Color fundus image, 1725x1721.
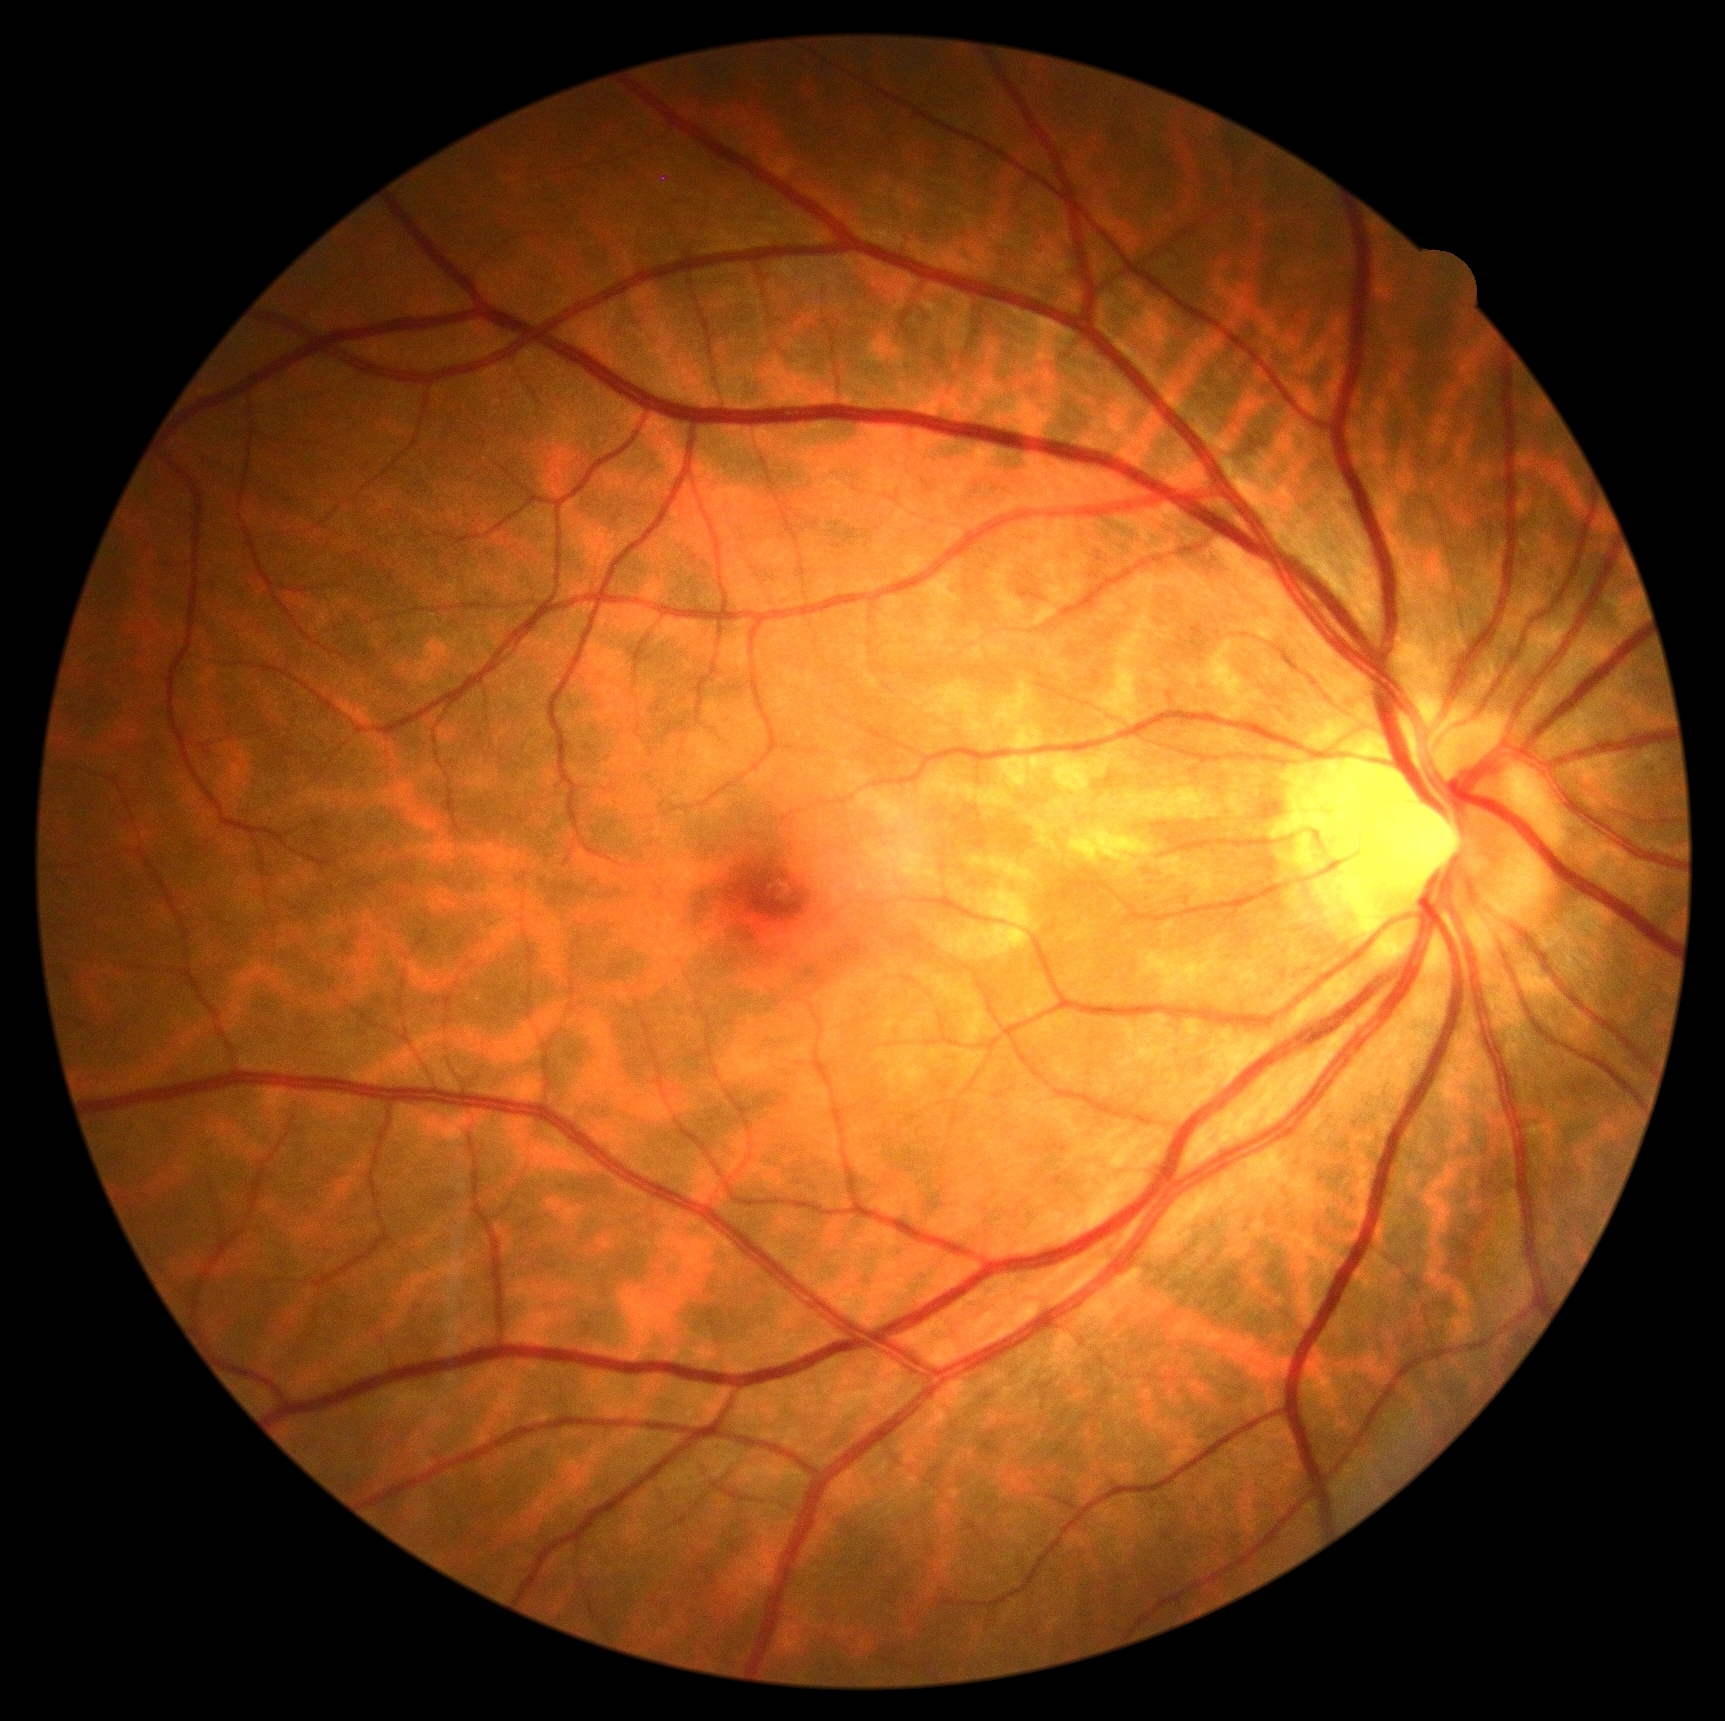 DR grade: no apparent diabetic retinopathy (0). No DR findings.